FOV: 45 degrees.
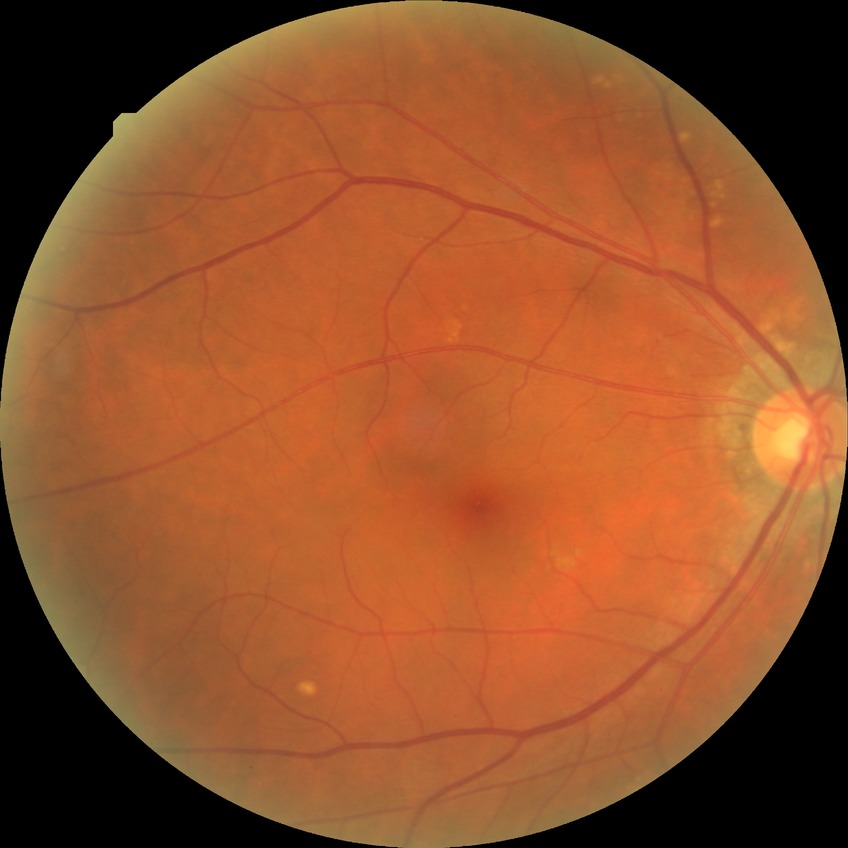 Diabetic retinopathy (DR): NDR (no diabetic retinopathy).